Captured with the Phoenix ICON (100° field of view). Image size 1240x1240. Wide-field fundus photograph from neonatal ROP screening
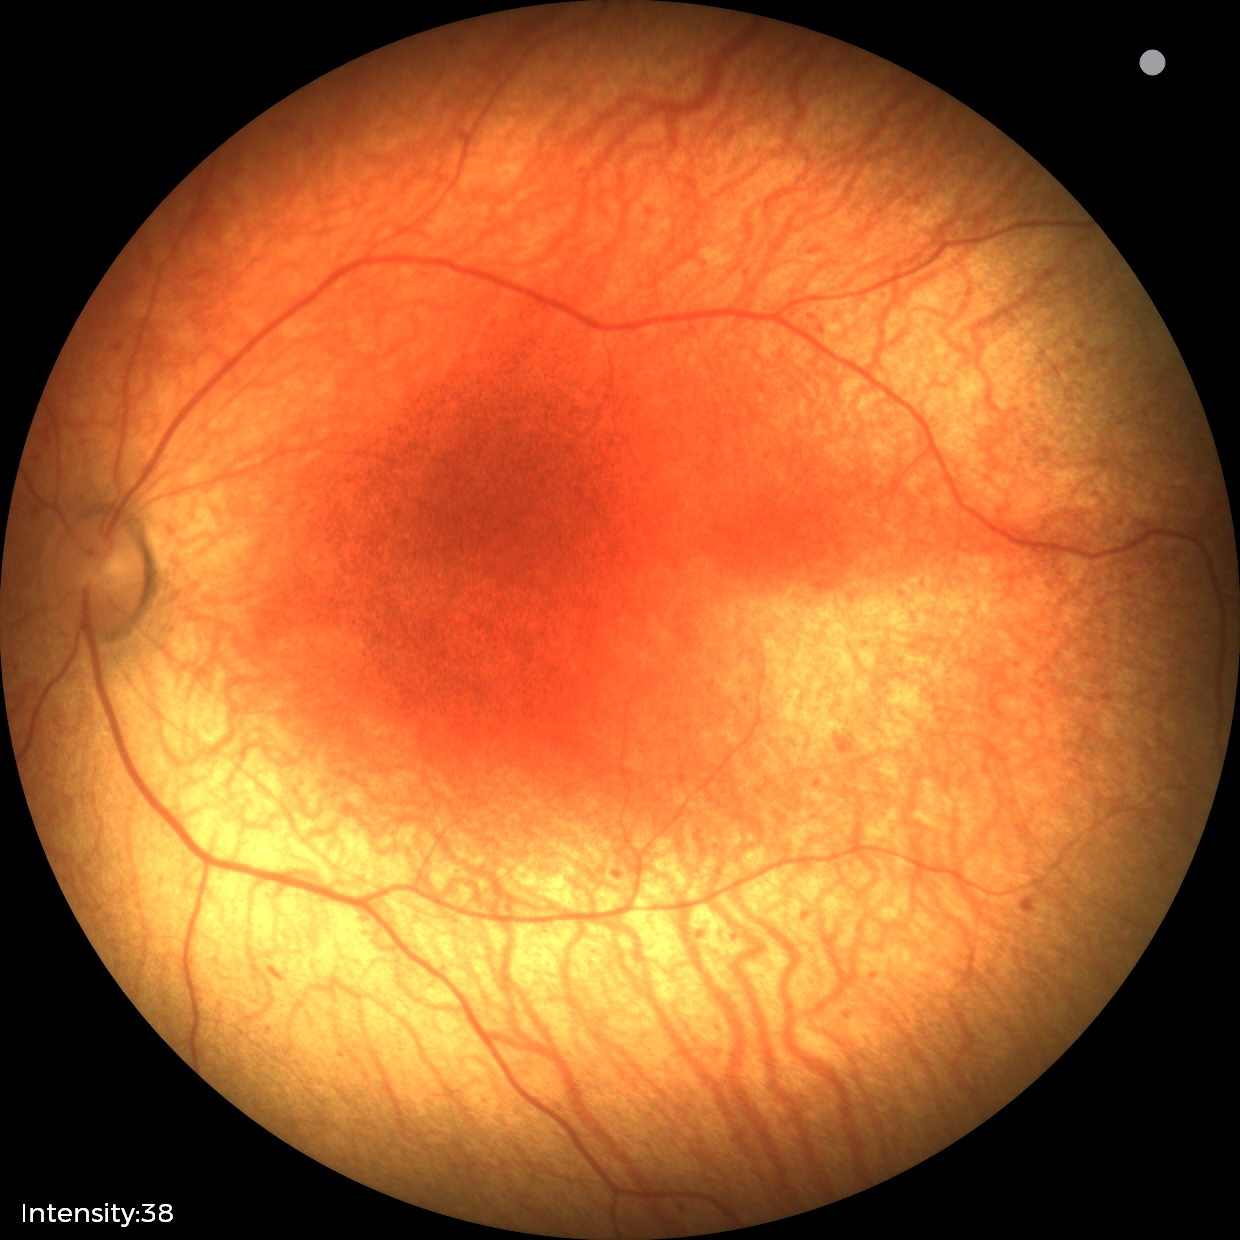

Without plus disease. Screening series with status post retinopathy of prematurity (ROP).